Wide-field fundus image from infant ROP screening — 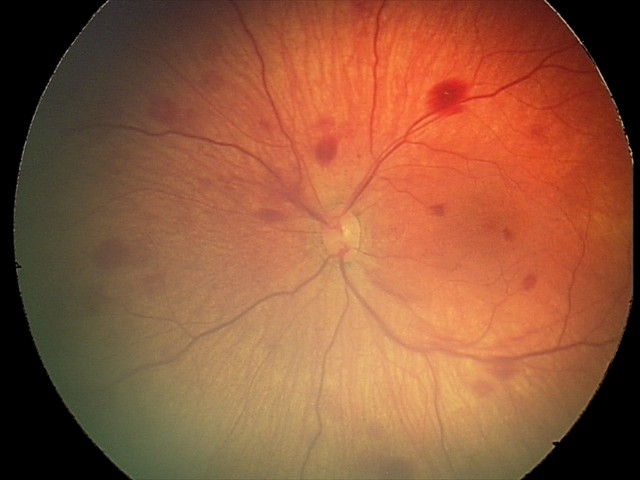

Diagnosis from this screening exam: retinal hemorrhages.